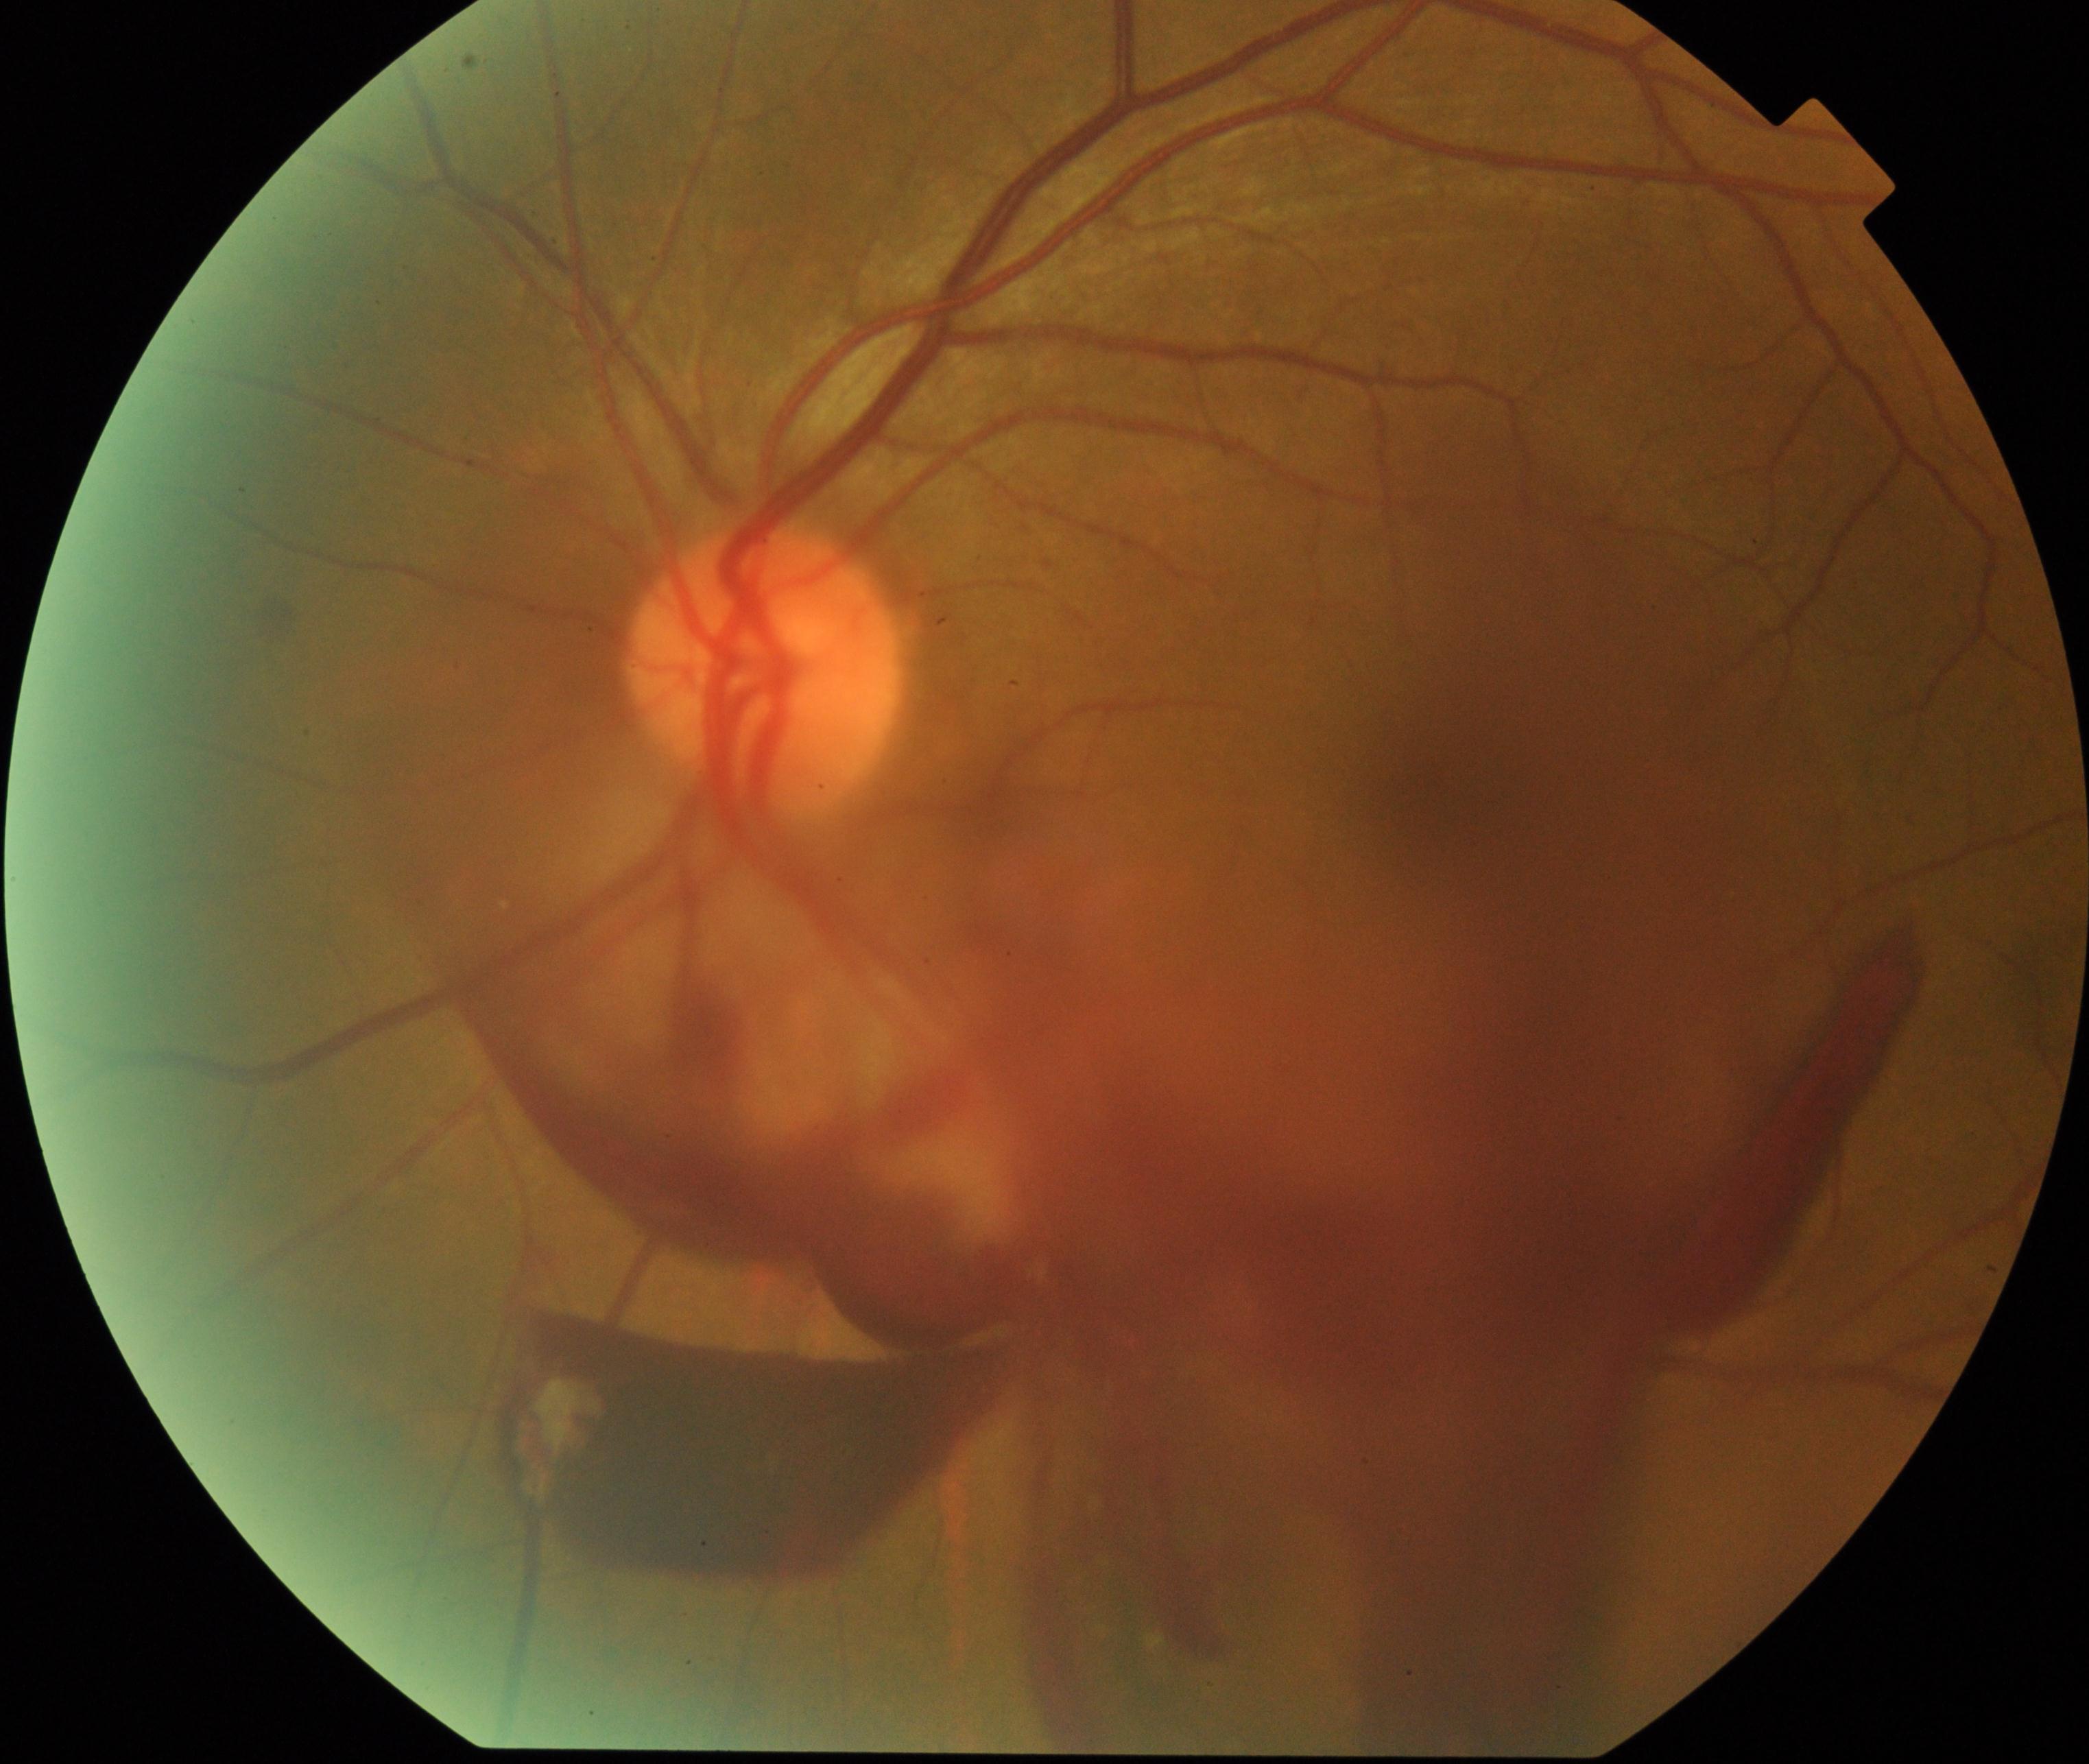
Consistent with preretinal hemorrhage. Typically showing usually a round red lesion that obscures all underlying retinal landmarks, sometimes with a boat-shaped crescentic configuration; the hemorrhage may break through into the vitreous.